Image size 848x848 — 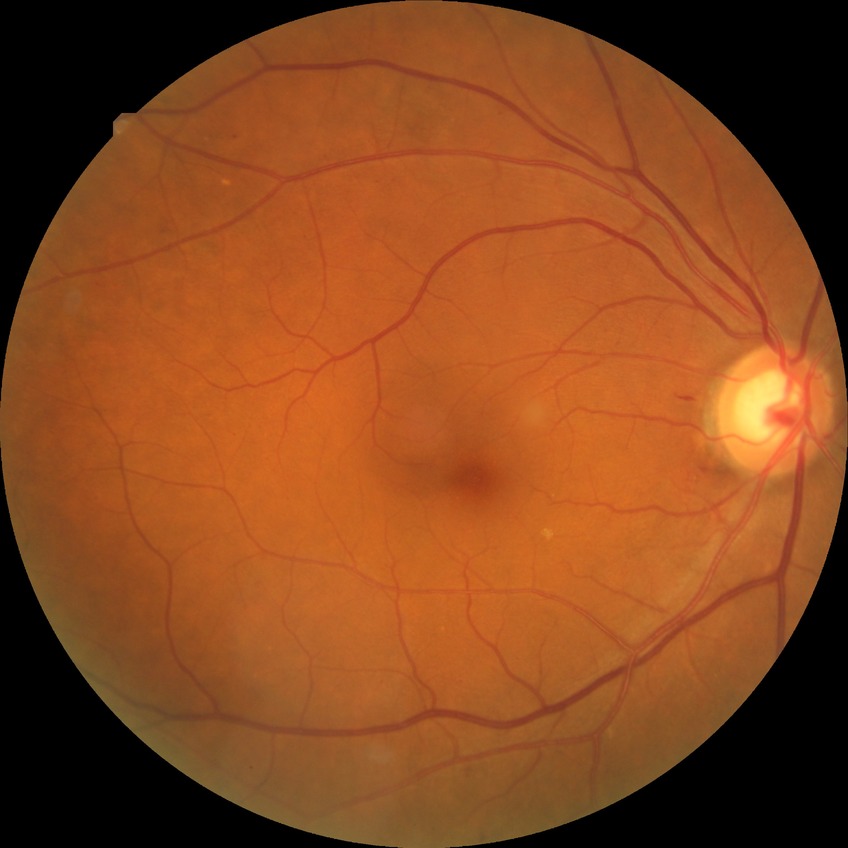

Diabetic retinopathy (DR) is simple diabetic retinopathy (SDR).